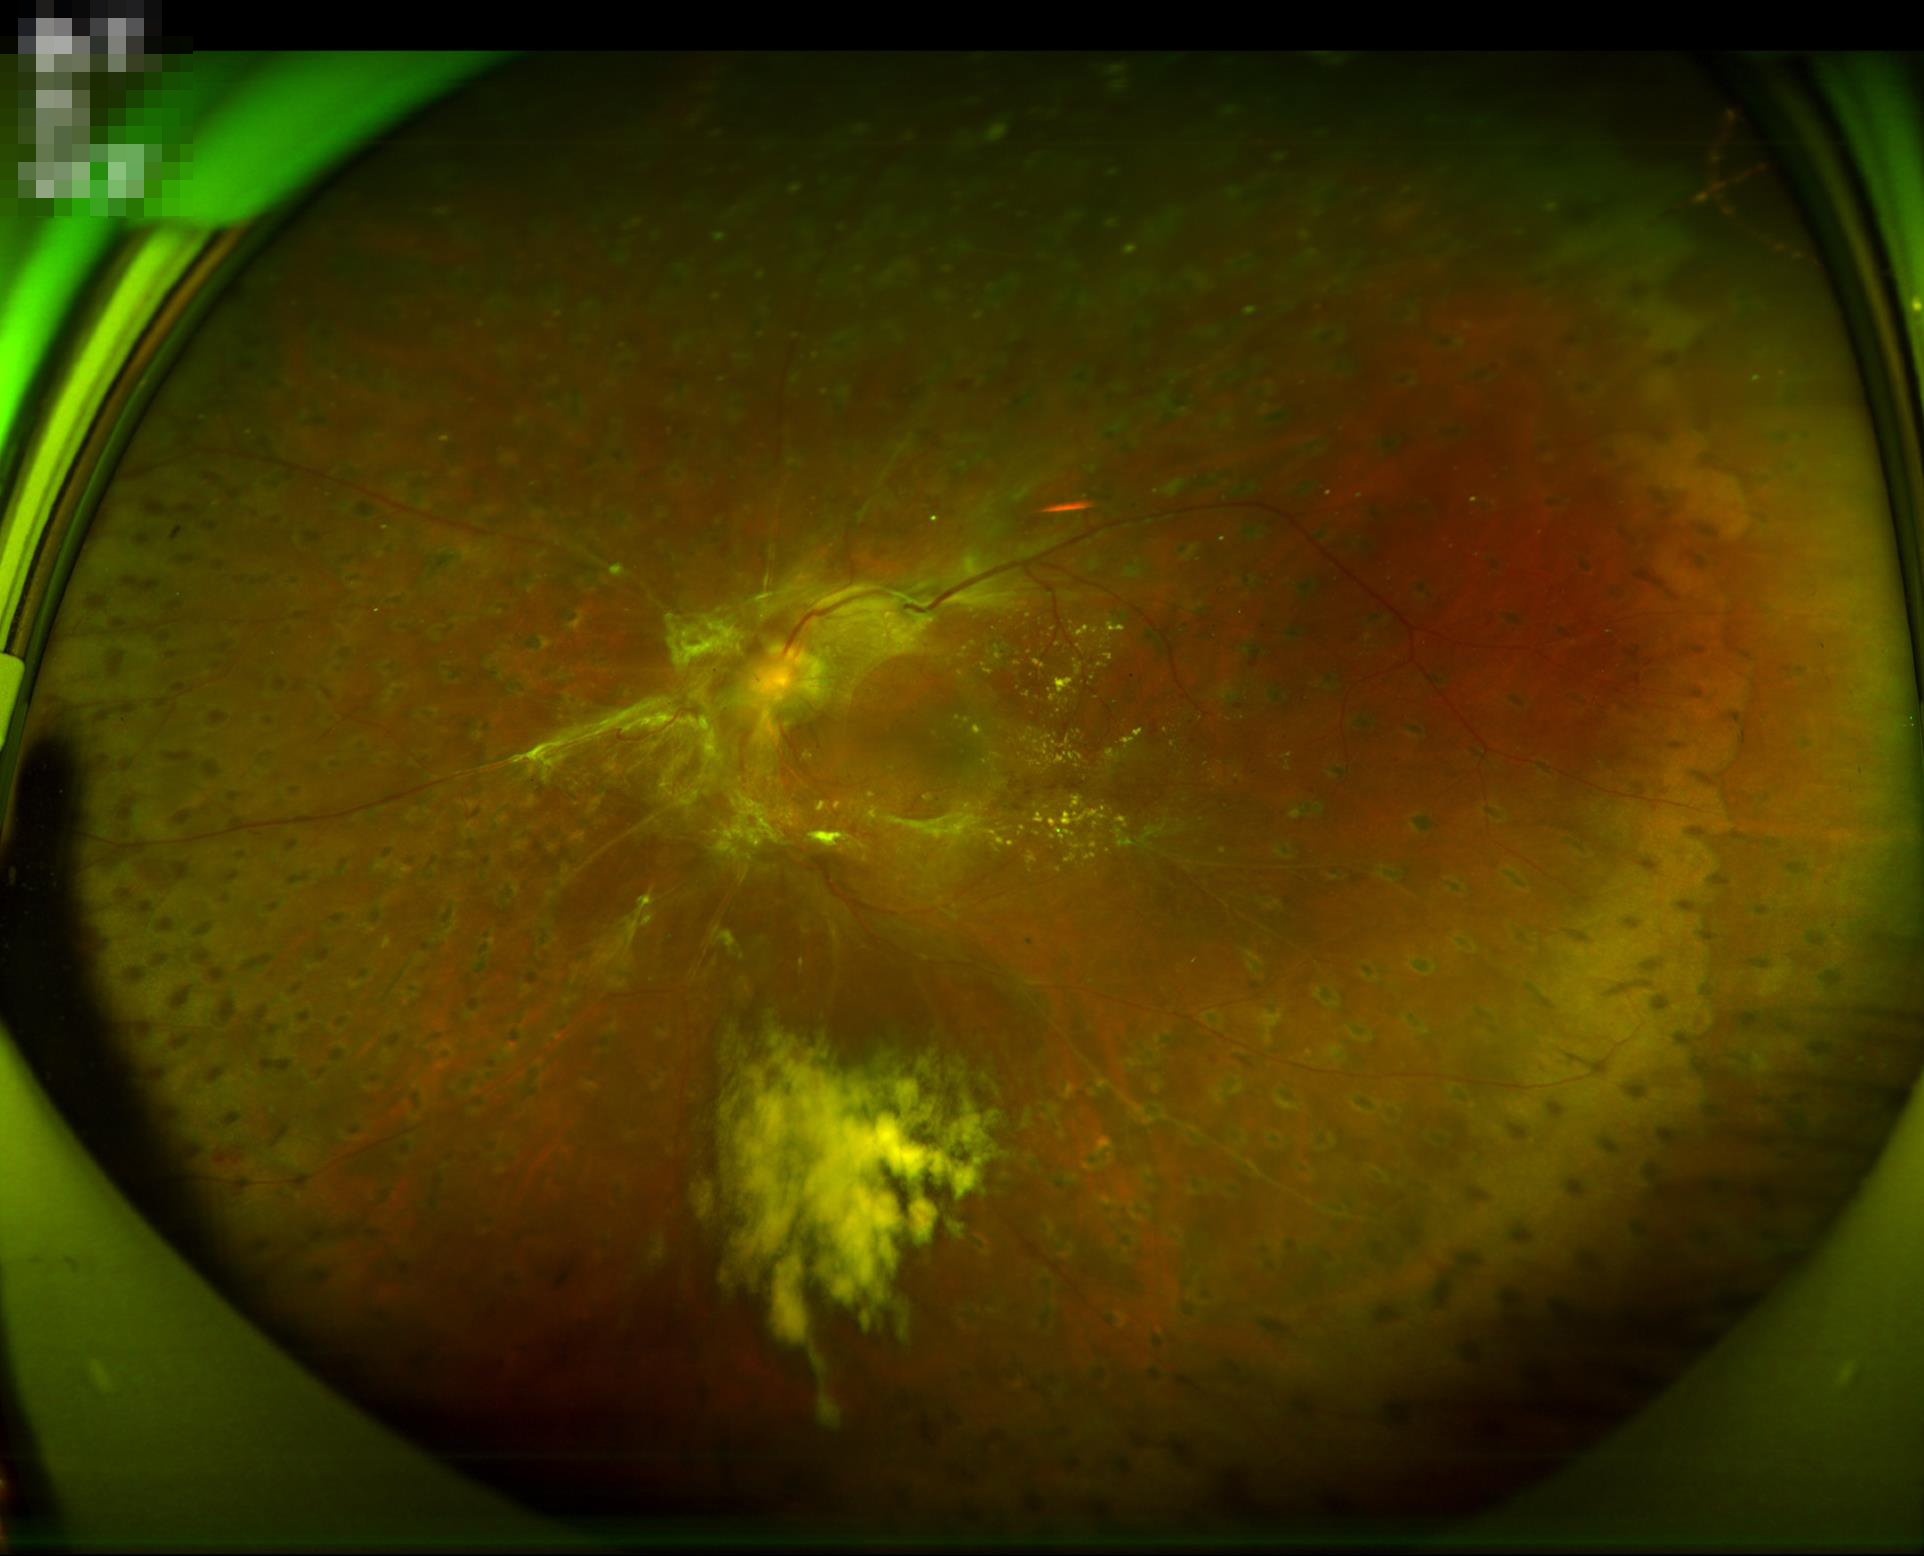

Out of focus; structures are indistinct.
Image quality is inadequate for diagnostic use.
Adequate contrast for distinguishing structures.
No over- or under-exposure.